Captured with the Clarity RetCam 3 (130° field of view); pediatric wide-field fundus photograph:
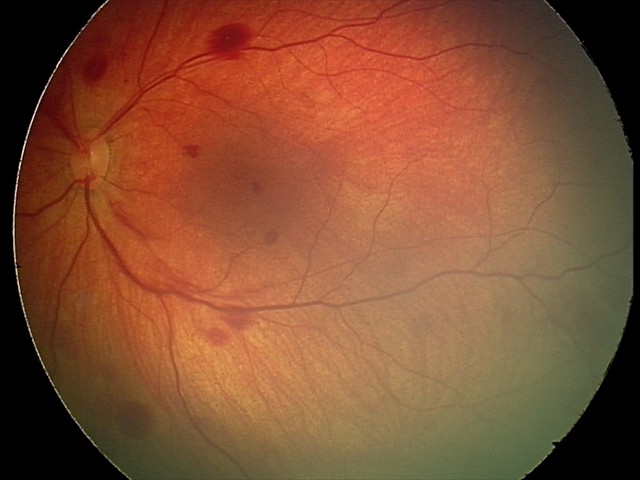
Finding: retinal hemorrhages